Without pupil dilation:
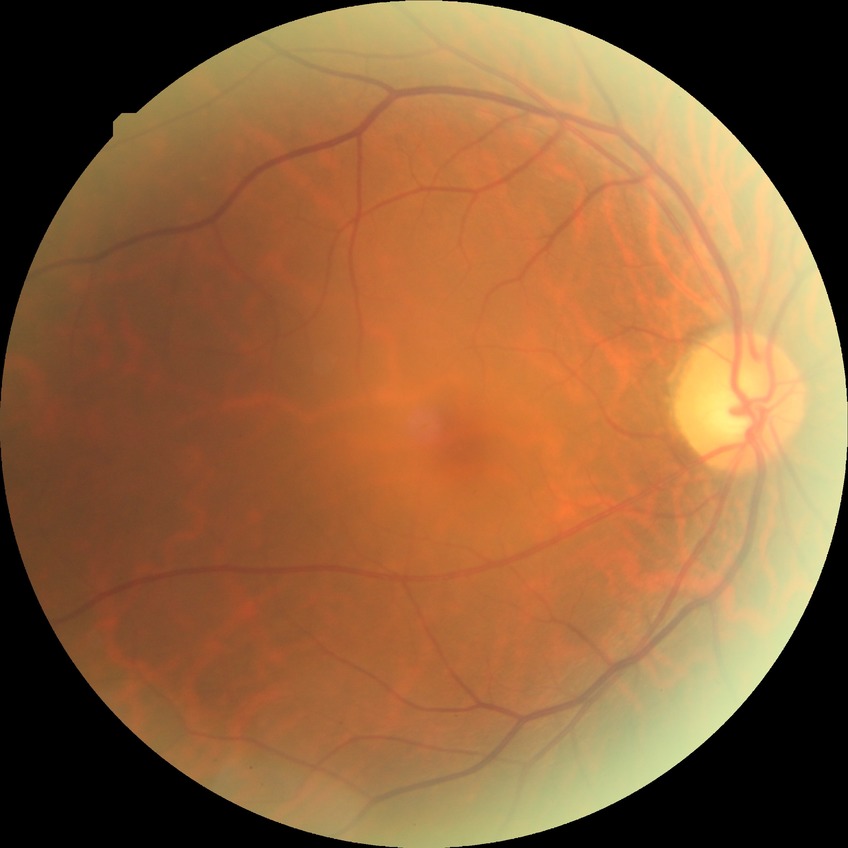 DR is NDR.
No DR findings.